Wide-field fundus photograph from neonatal ROP screening:
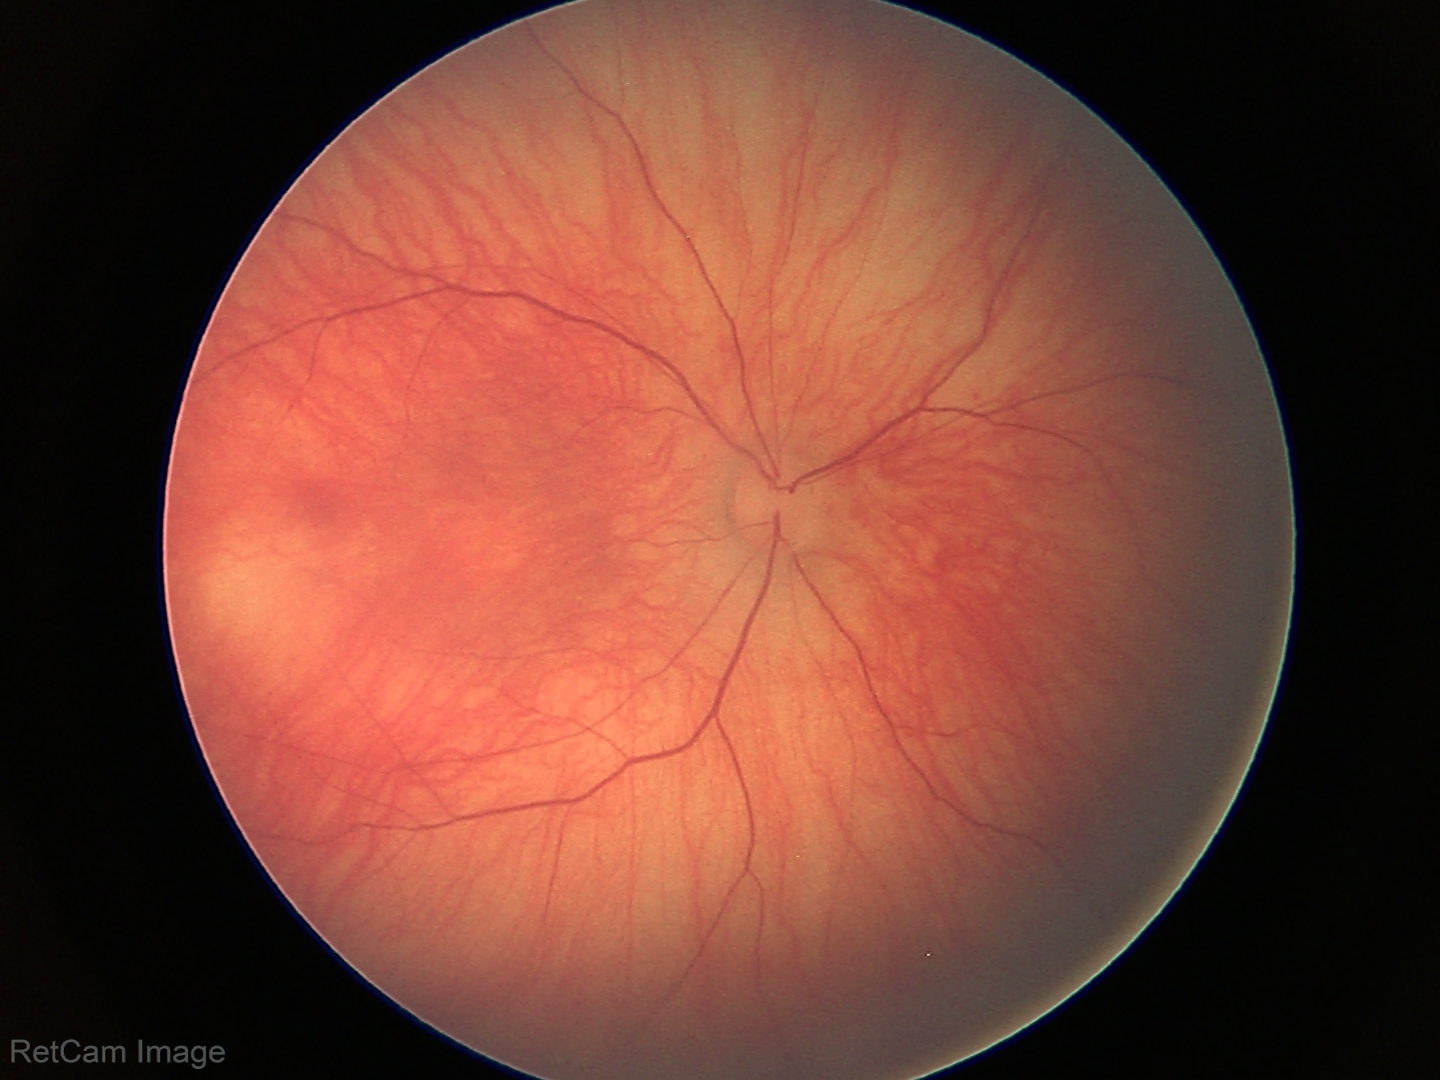 Examination with physiological retinal findings.